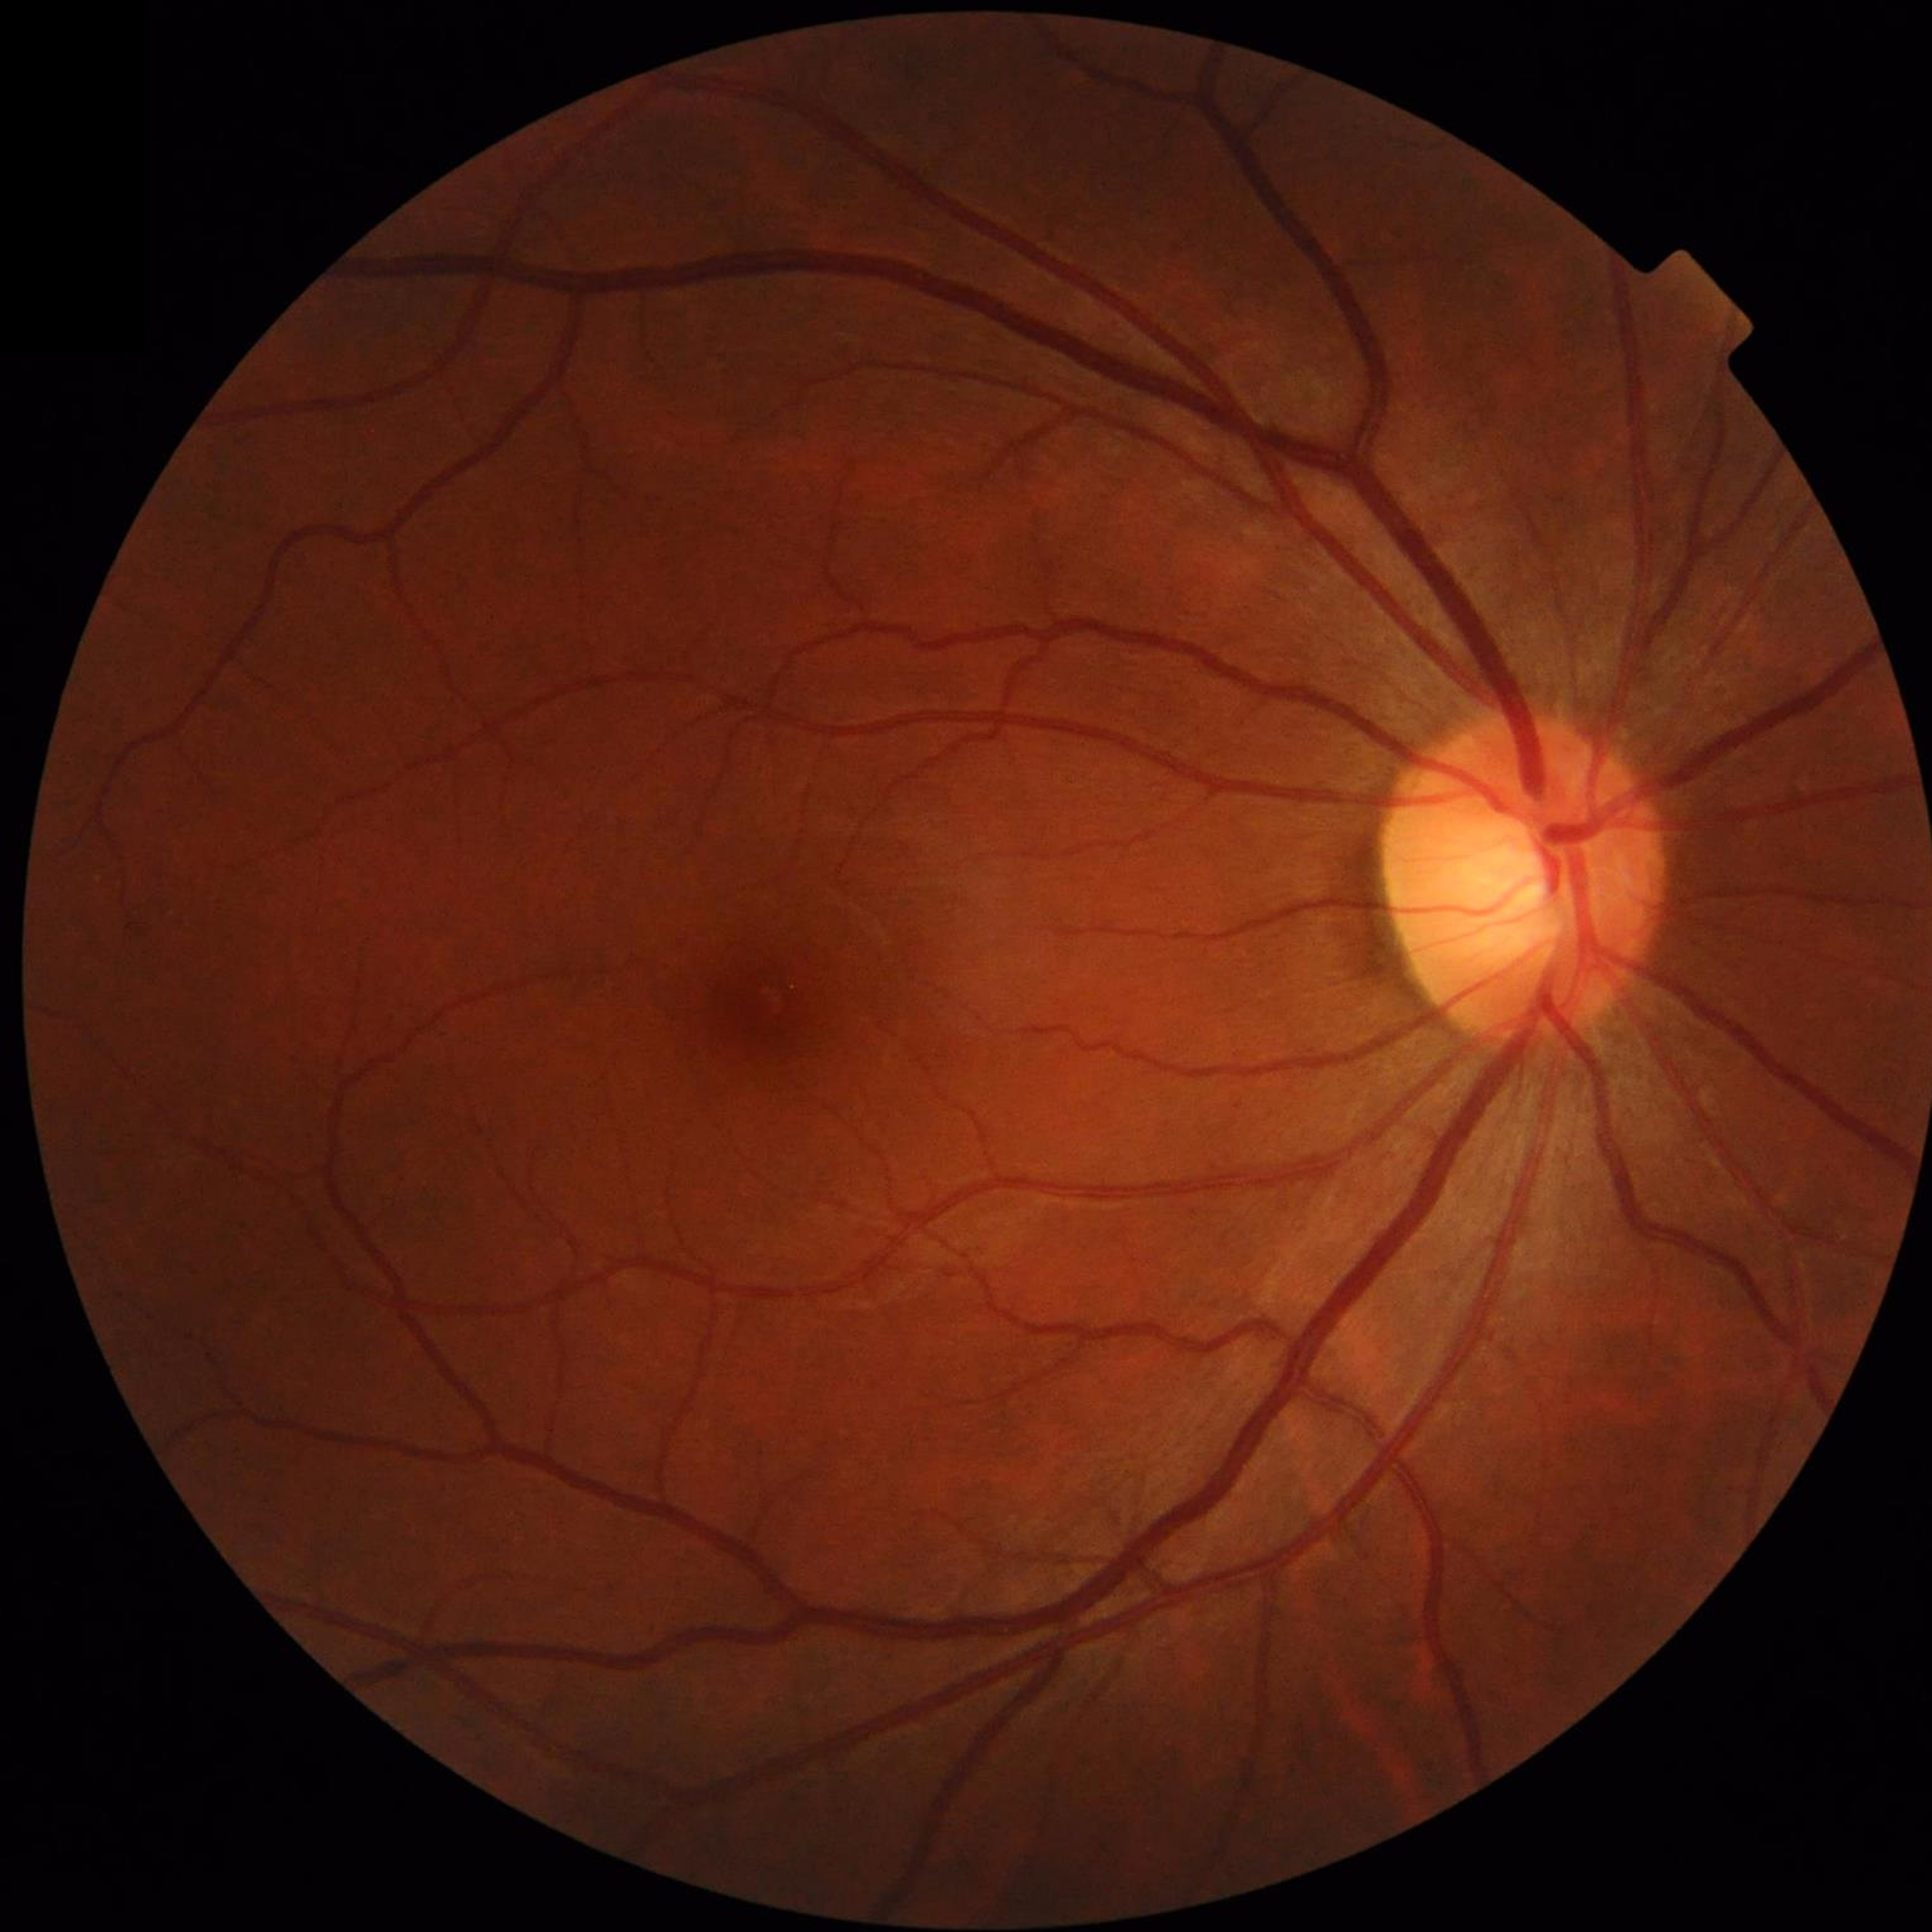
No AMD, DR, or glaucomatous findings.